1659 x 2212 pixels; camera: Remidio Fundus on Phone (FOP) camera: 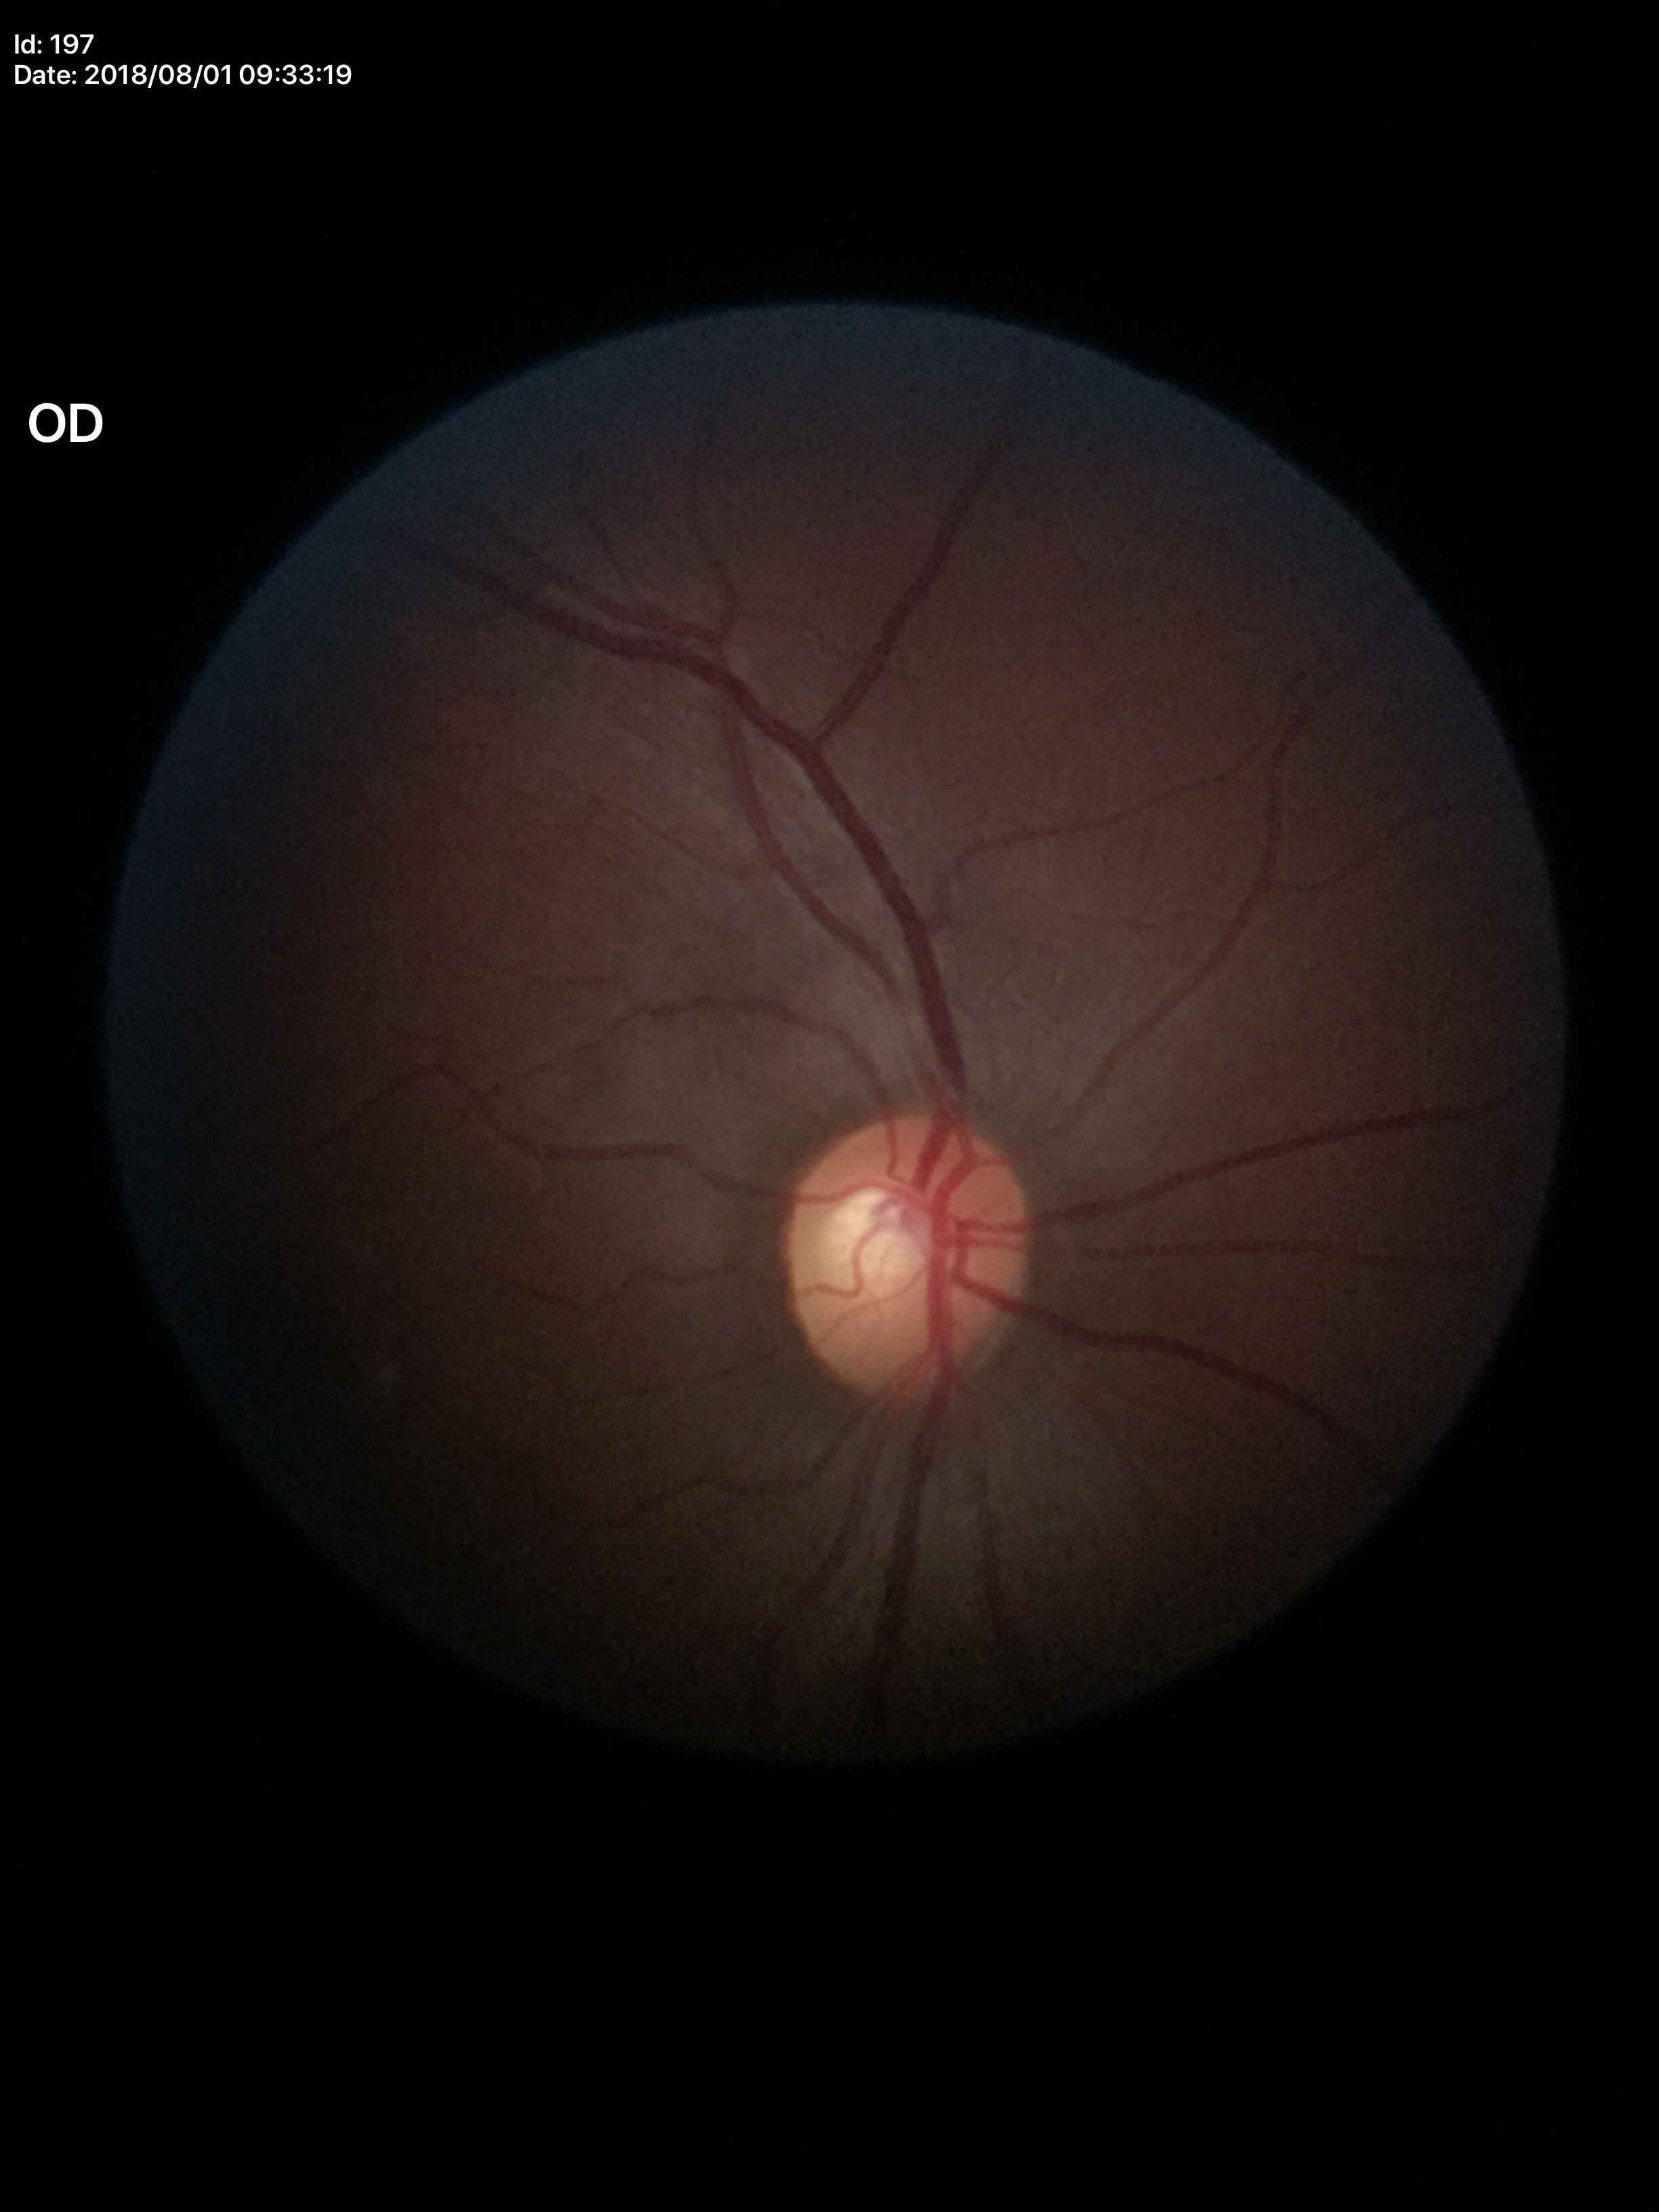
Glaucoma screening = negative (5/5 ophthalmologists in agreement)
VCDR = 0.52
HCDR = 0.58